Nonmydriatic · NIDEK AFC-230
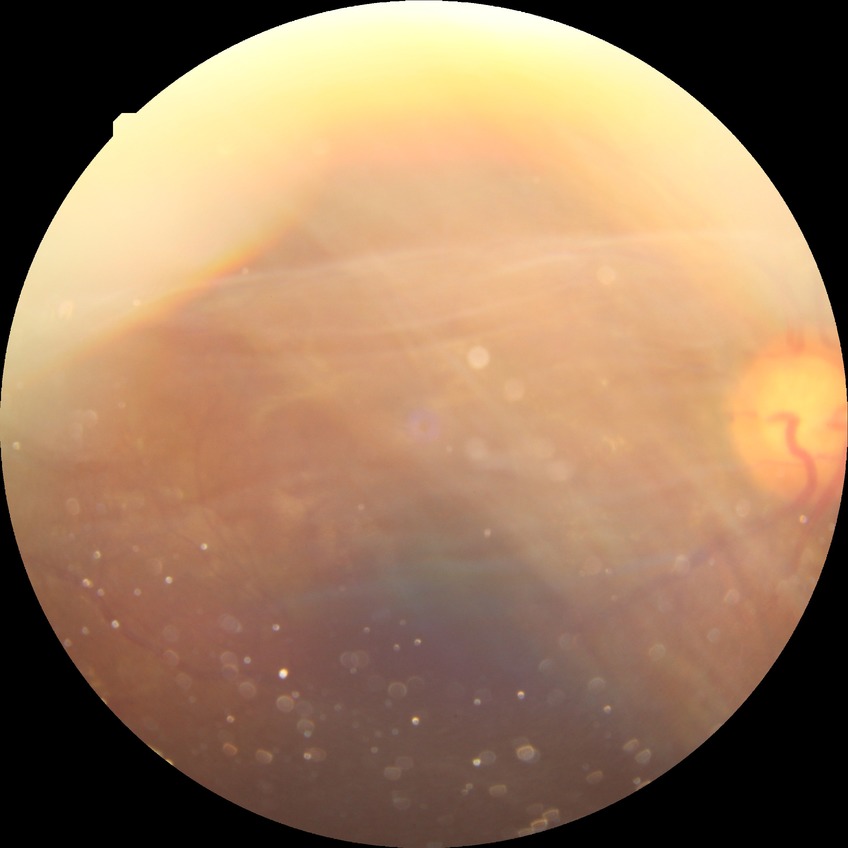 diabetic retinopathy (DR): proliferative diabetic retinopathy (PDR).